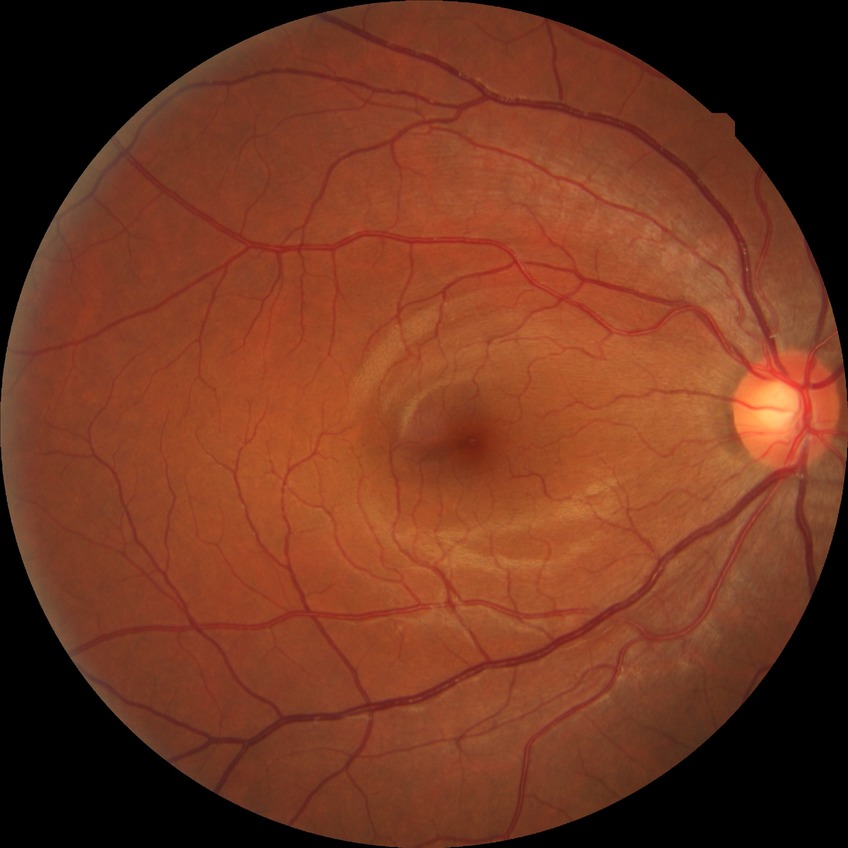 {"davis_grade": "no diabetic retinopathy (NDR)"}